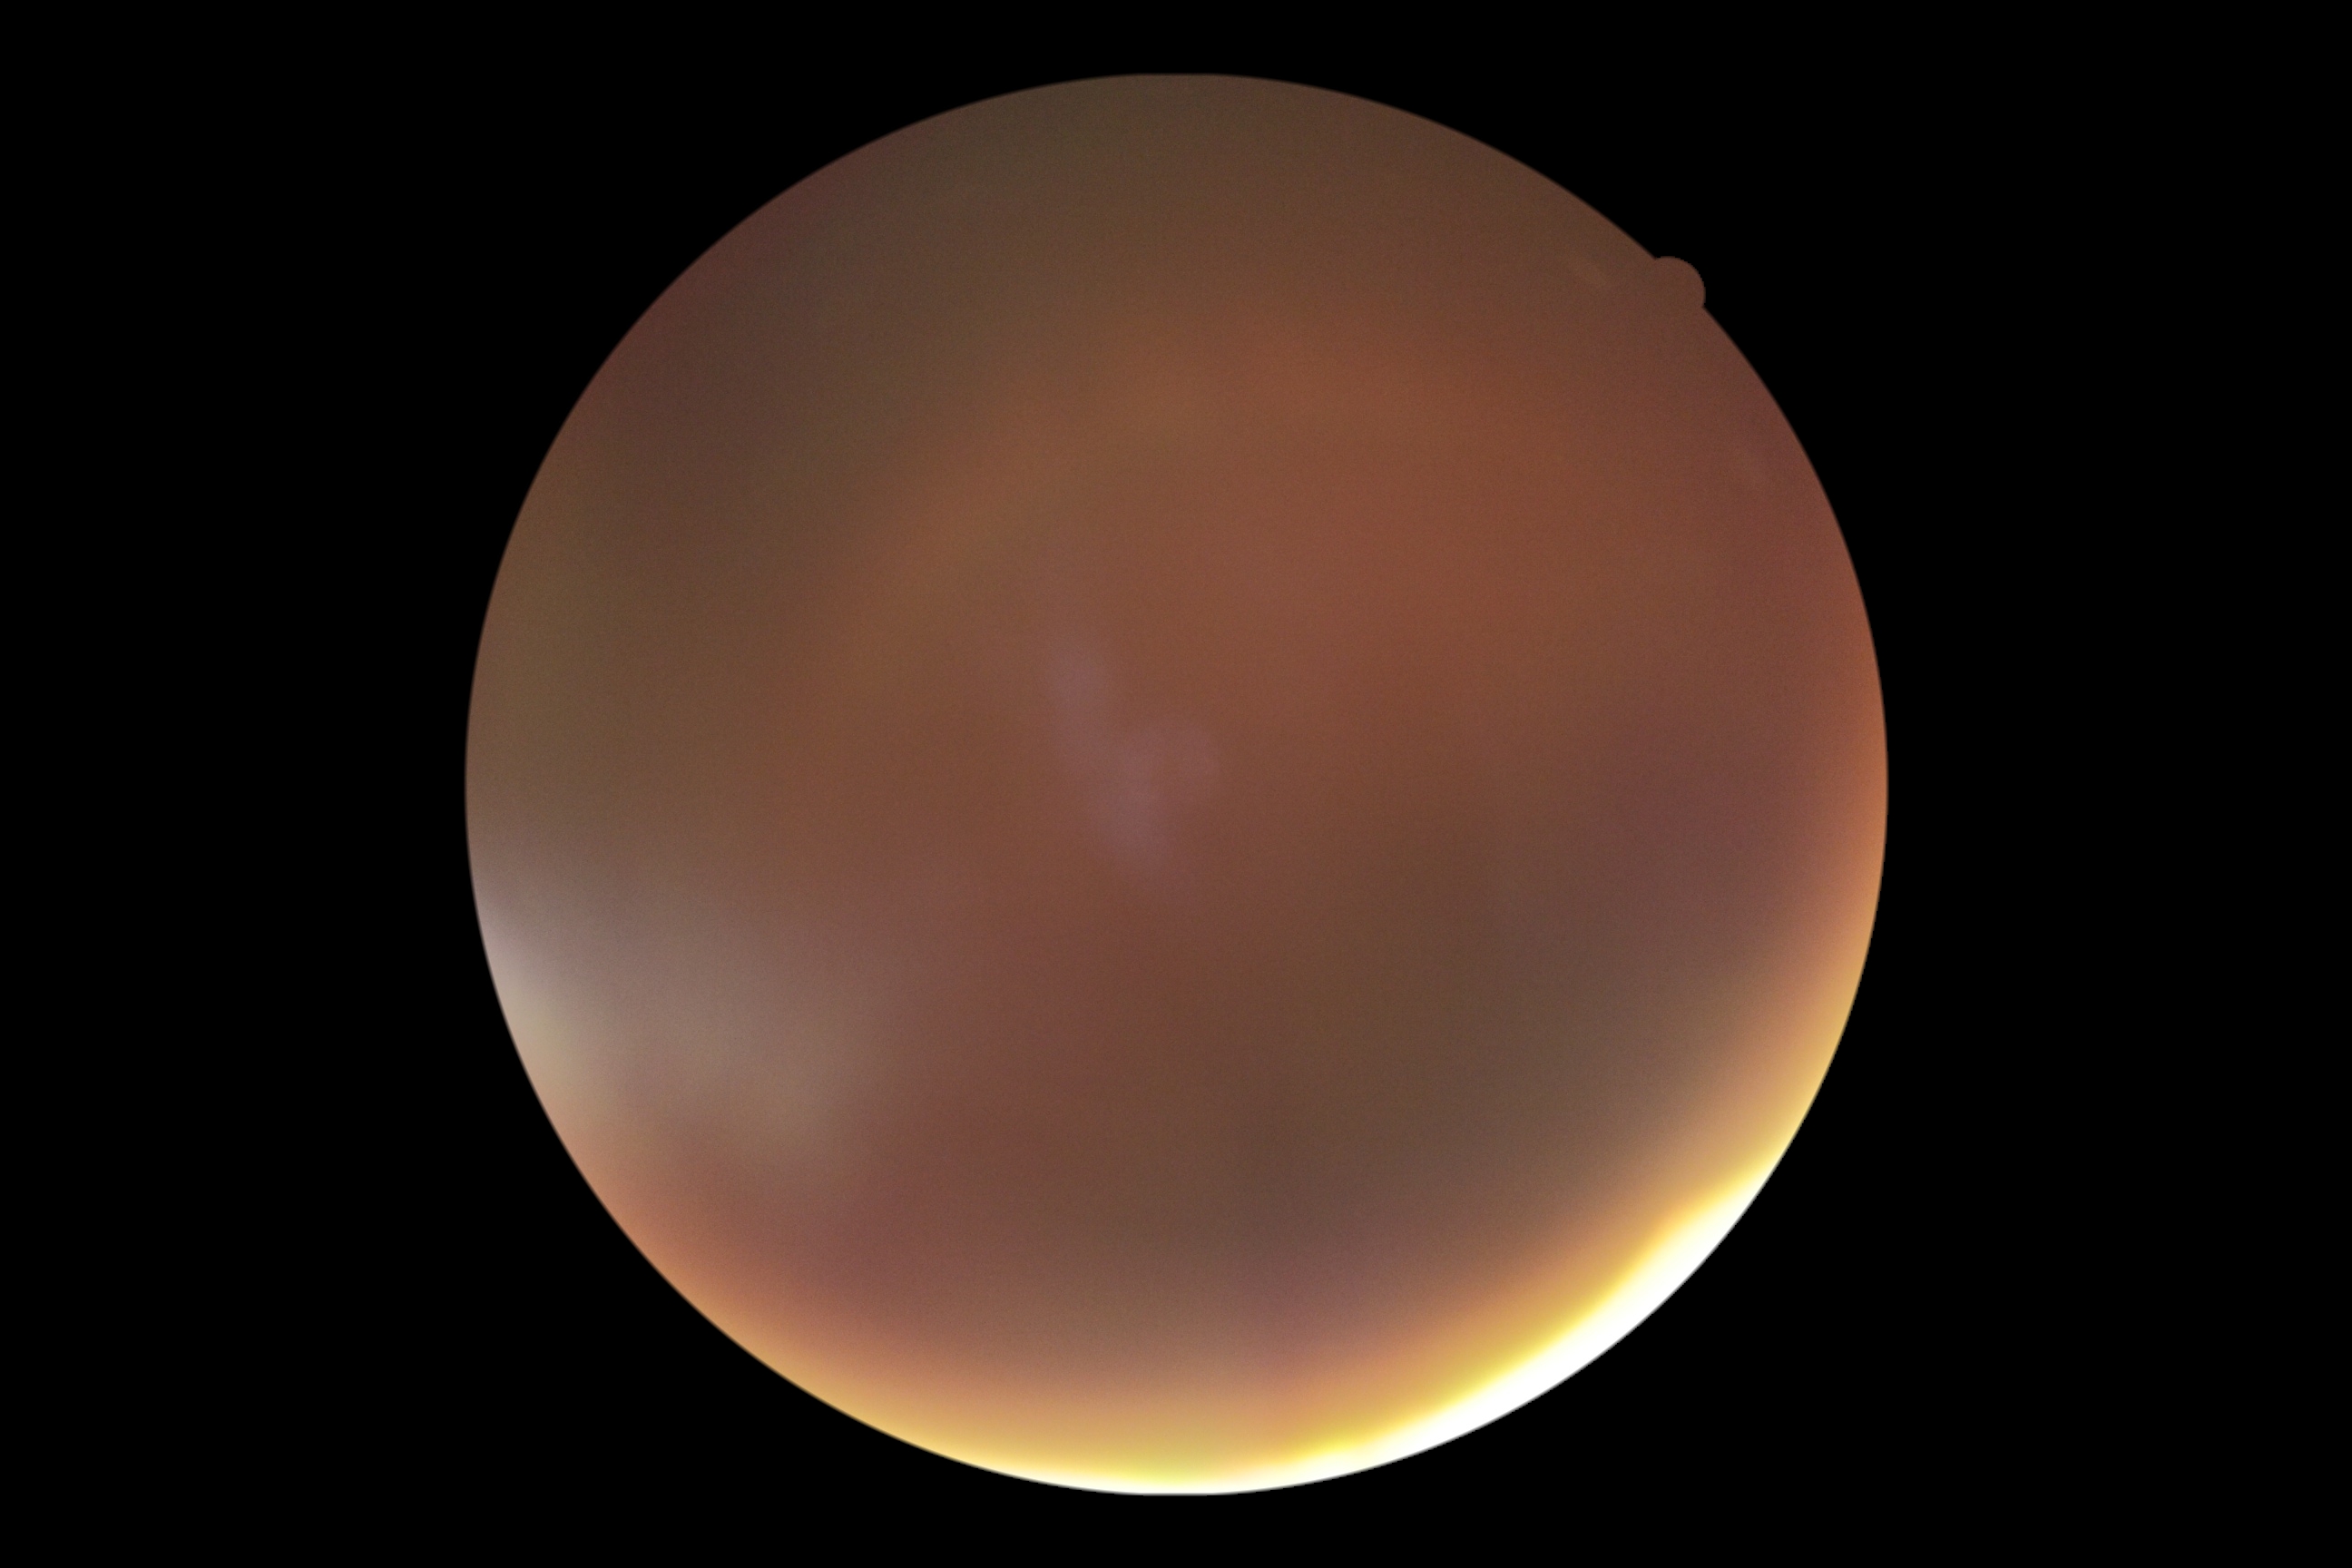 Diabetic retinopathy (DR): ungradable due to poor image quality.